Image size 848x848. Modified Davis grading. Fundus photo.
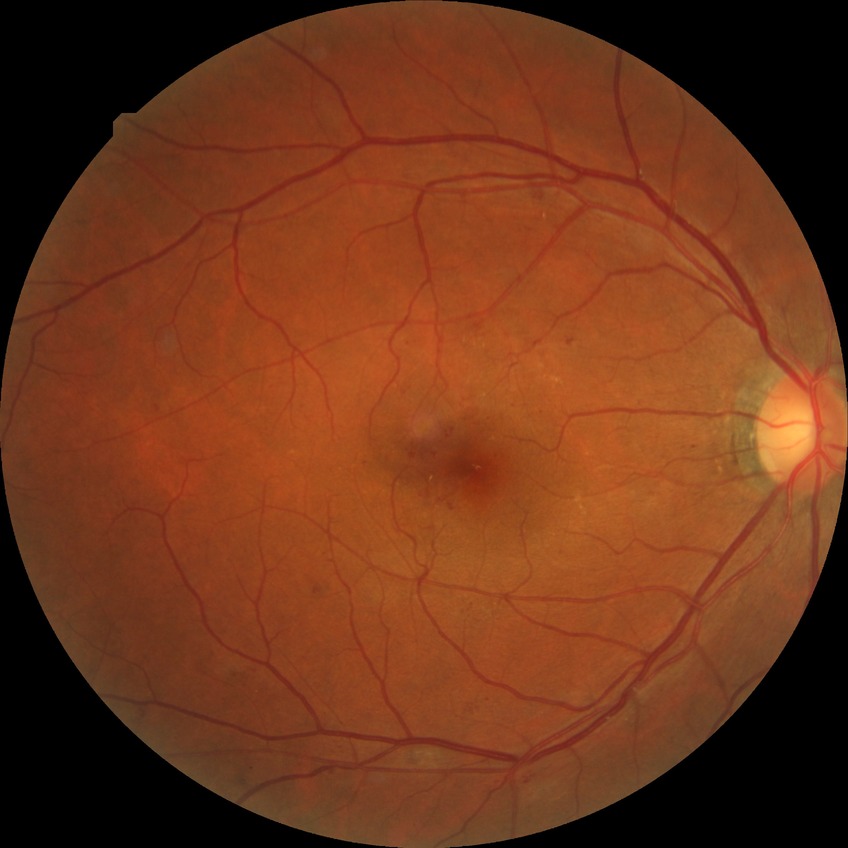 Davis stage: SDR.